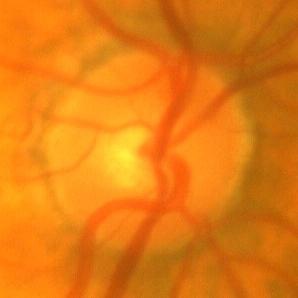 No glaucoma.